DR severity per modified Davis staging · 45° field of view: 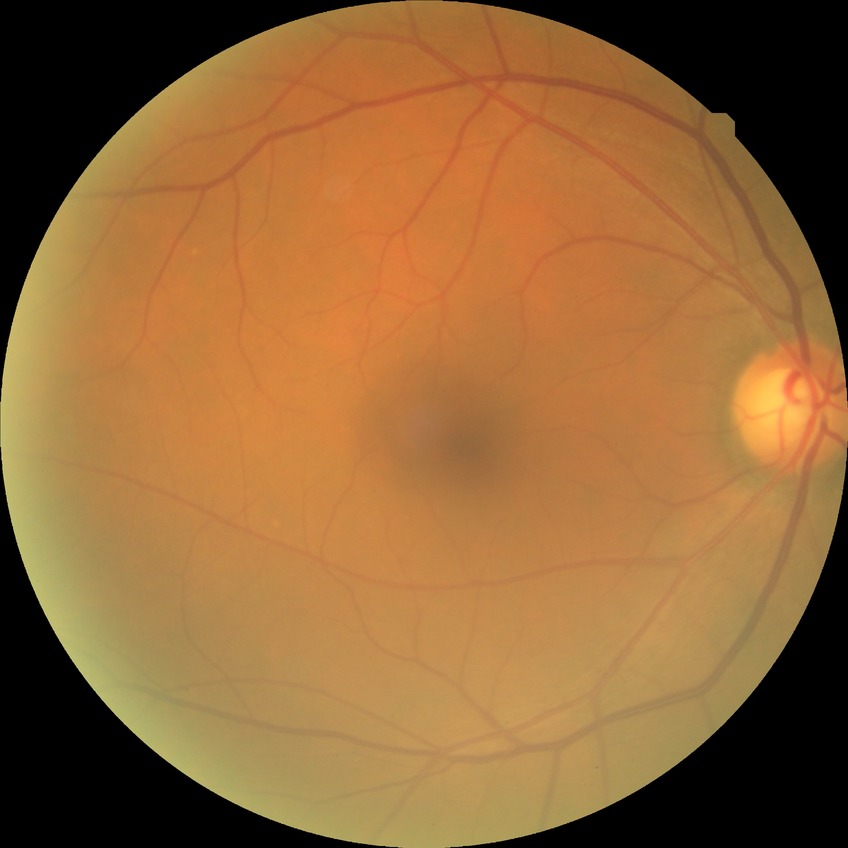 Diabetic retinopathy (DR) is no diabetic retinopathy (NDR).